Nonmydriatic fundus photograph · posterior pole color fundus photograph · 45 degree fundus photograph:
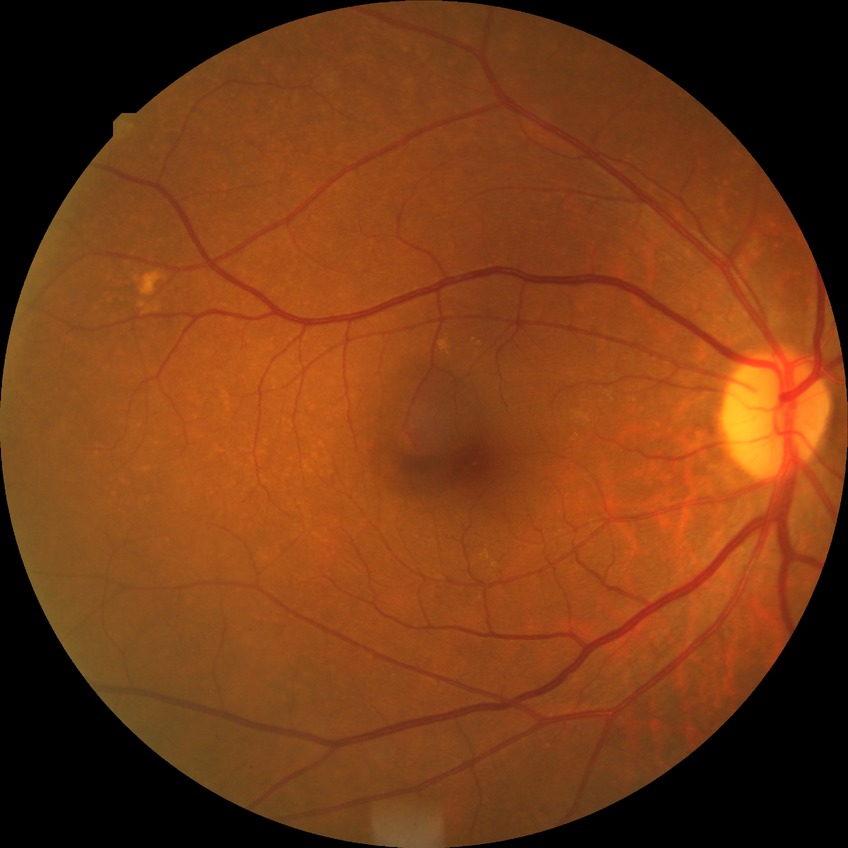 Annotations:
• DR stage: NDR
• DR impression: no DR findings